No pharmacologic dilation, retinal fundus photograph, 848 x 848 pixels, 45-degree field of view, camera: NIDEK AFC-230
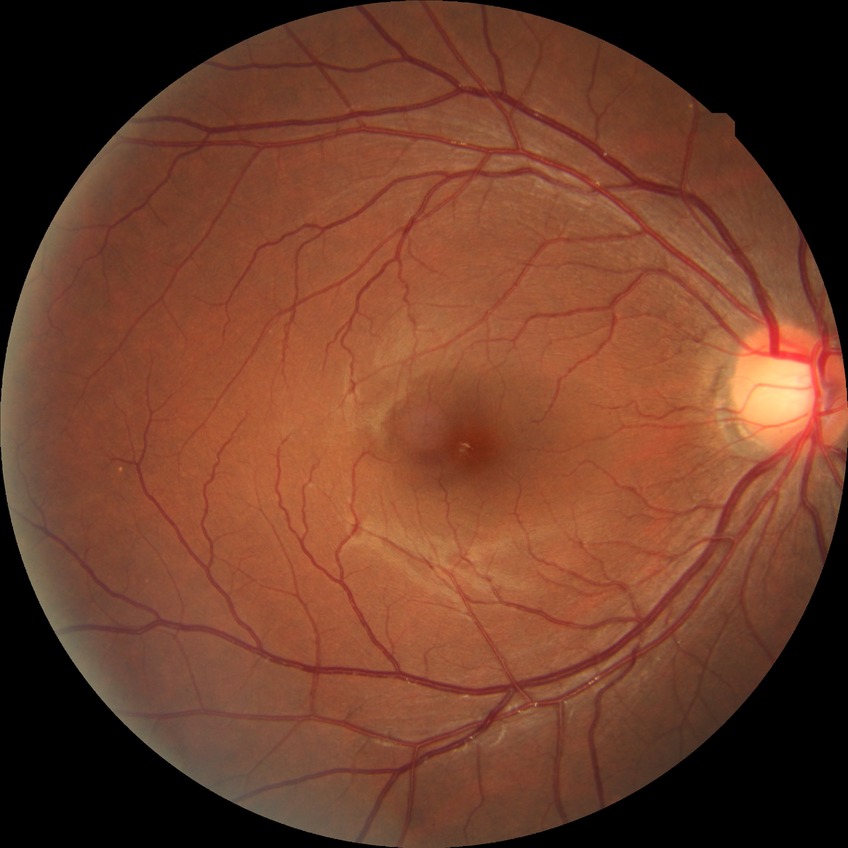 - diabetic retinopathy (DR) — no diabetic retinopathy (NDR)